Infant wide-field retinal image · acquired on the Clarity RetCam 3 · 640x480px
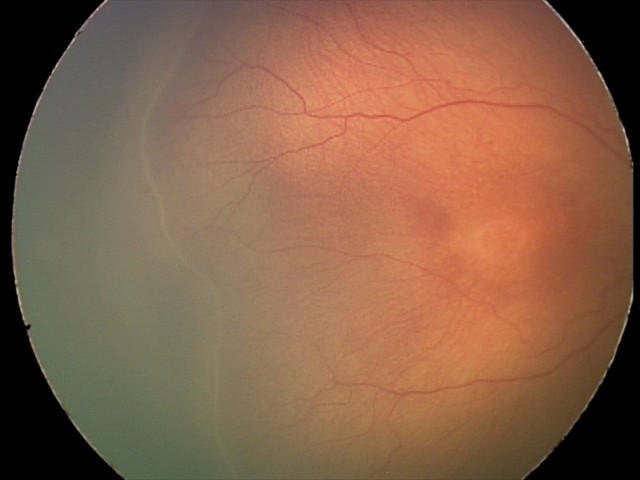

From an examination with diagnosis of retinopathy of prematurity (ROP) stage 2 — ridge with height and width at the demarcation line. Without plus disease.